Wide-field fundus photograph of an infant — 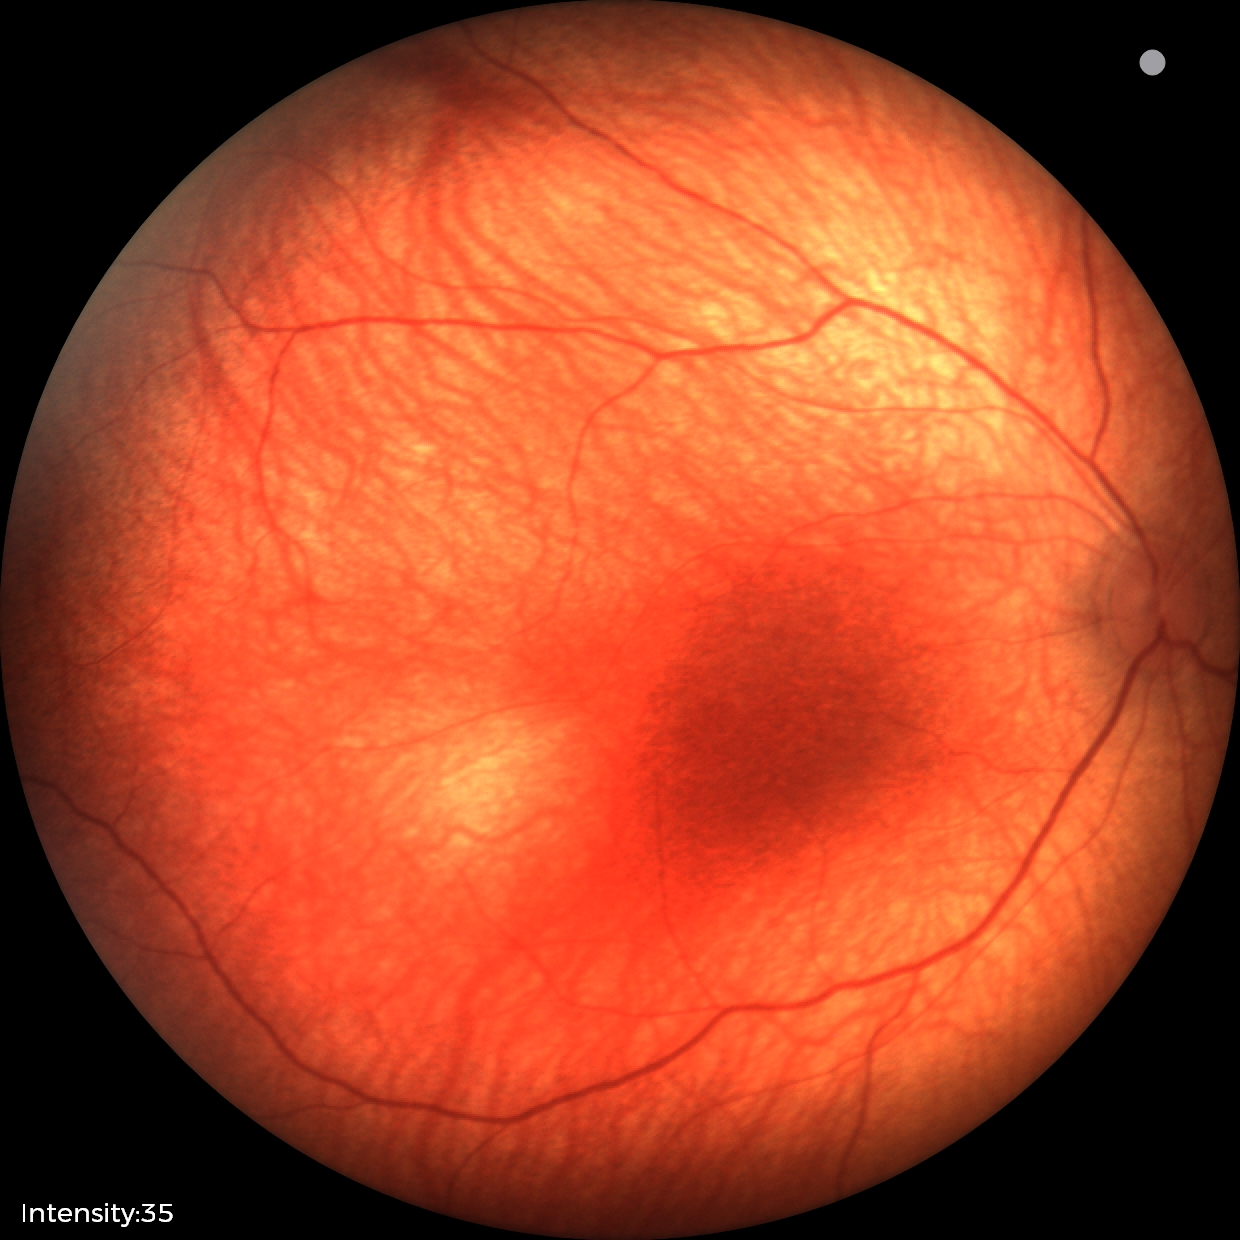 Screening: physiological retinal finding.